Disc-centered fundus crop · dilated pupil · cropped from a 35-degree field of view — 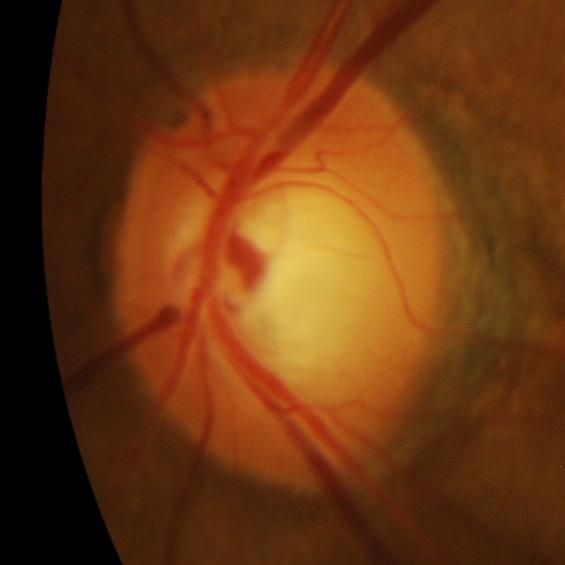 Glaucomatous optic neuropathy is present.
Glaucomatous changes.